Forus 3Nethra Classic fundus camera
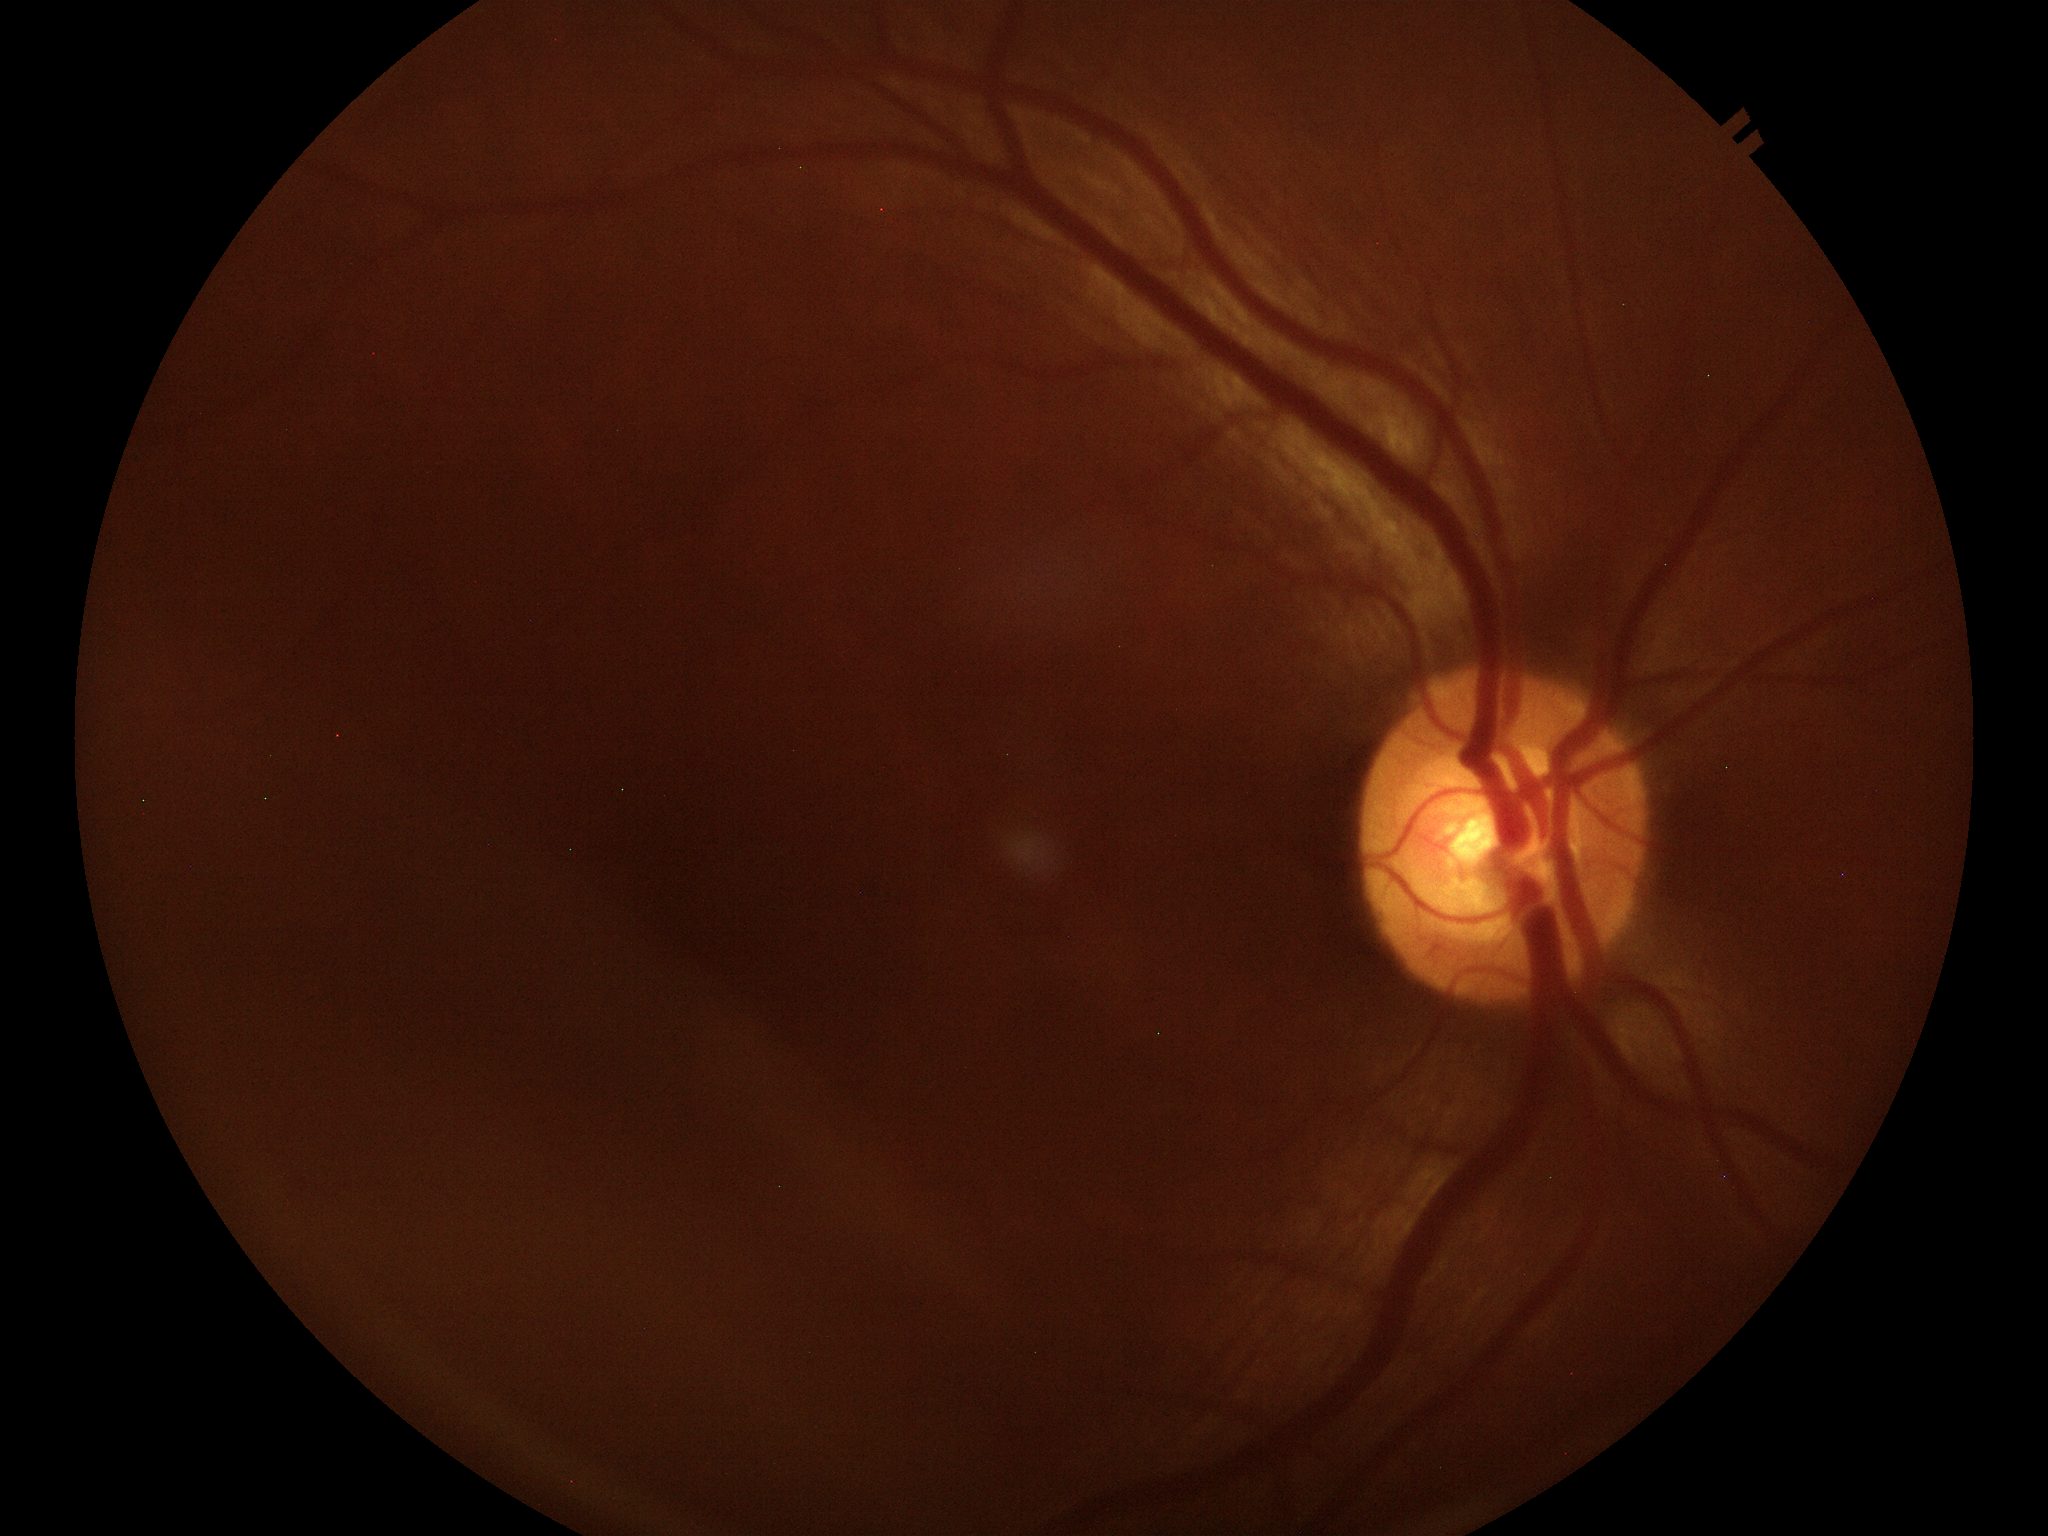 Optic disc analysis:
– Glaucoma decision · not suspect
– vertical CDR (VCDR) · 0.55
– horizontal cup-disc ratio (HCDR) · 0.57
– area cup-to-disc ratio (ACDR) · 0.31